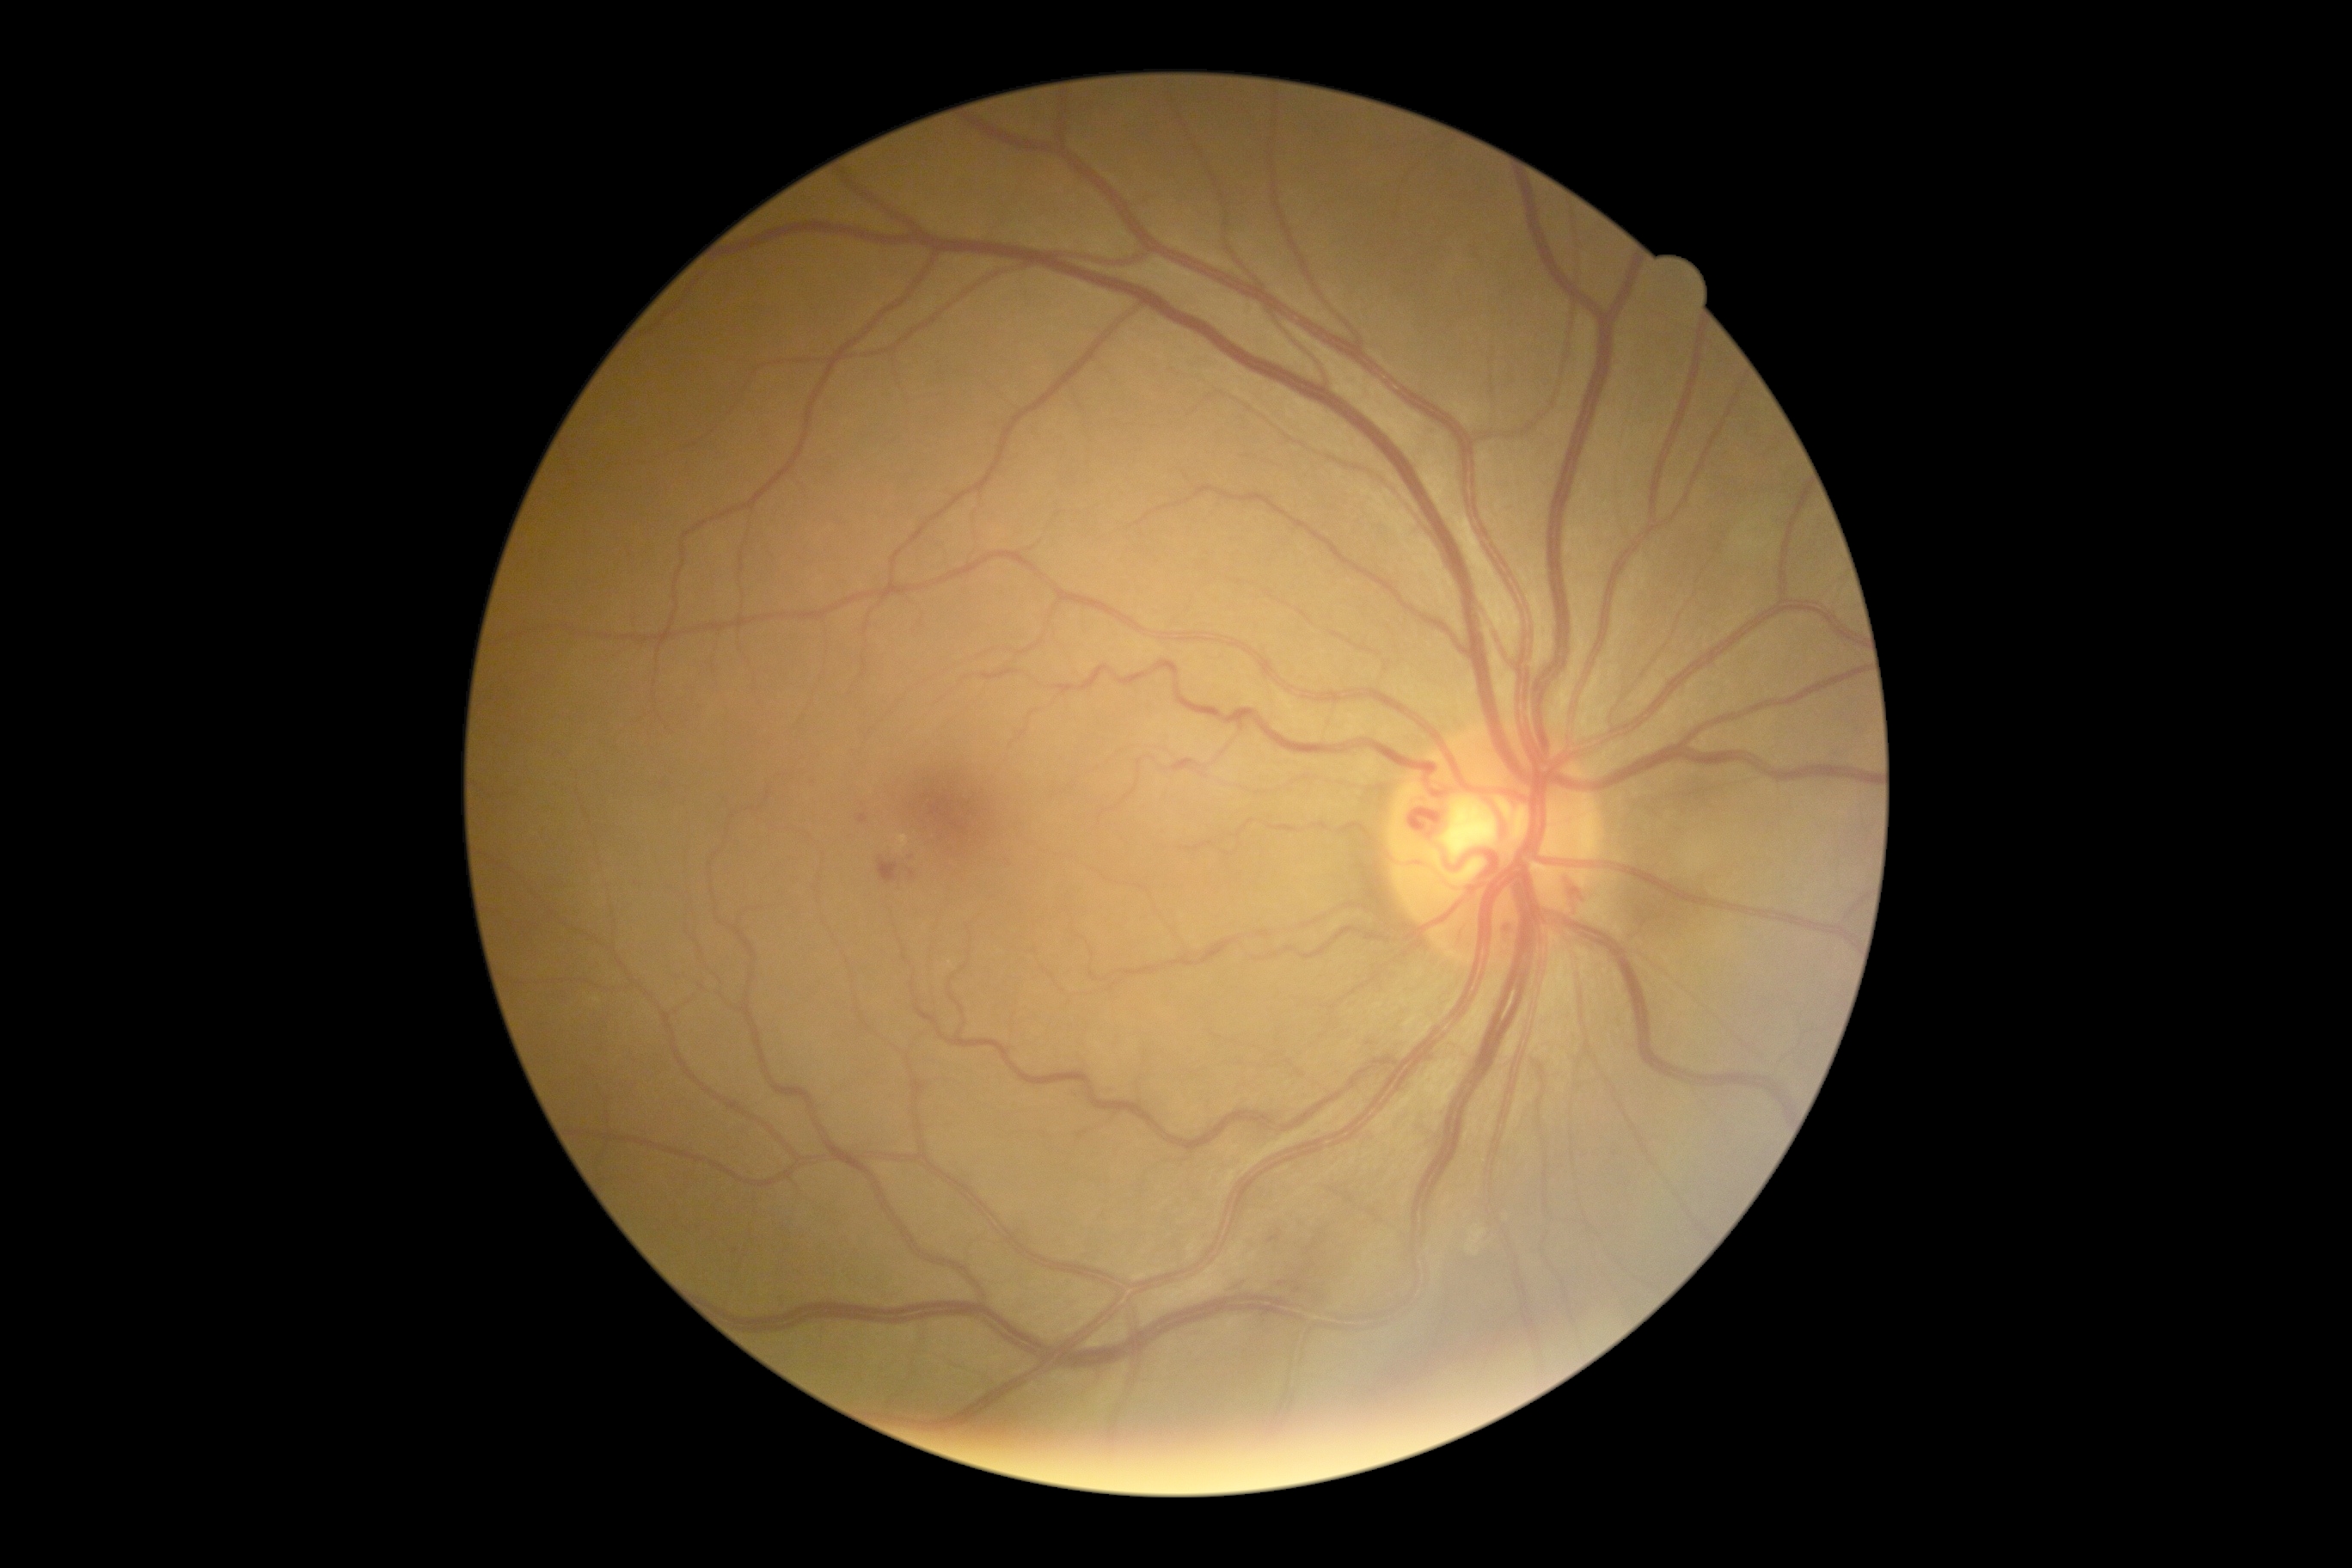
Diabetic retinopathy grade: 2/4.